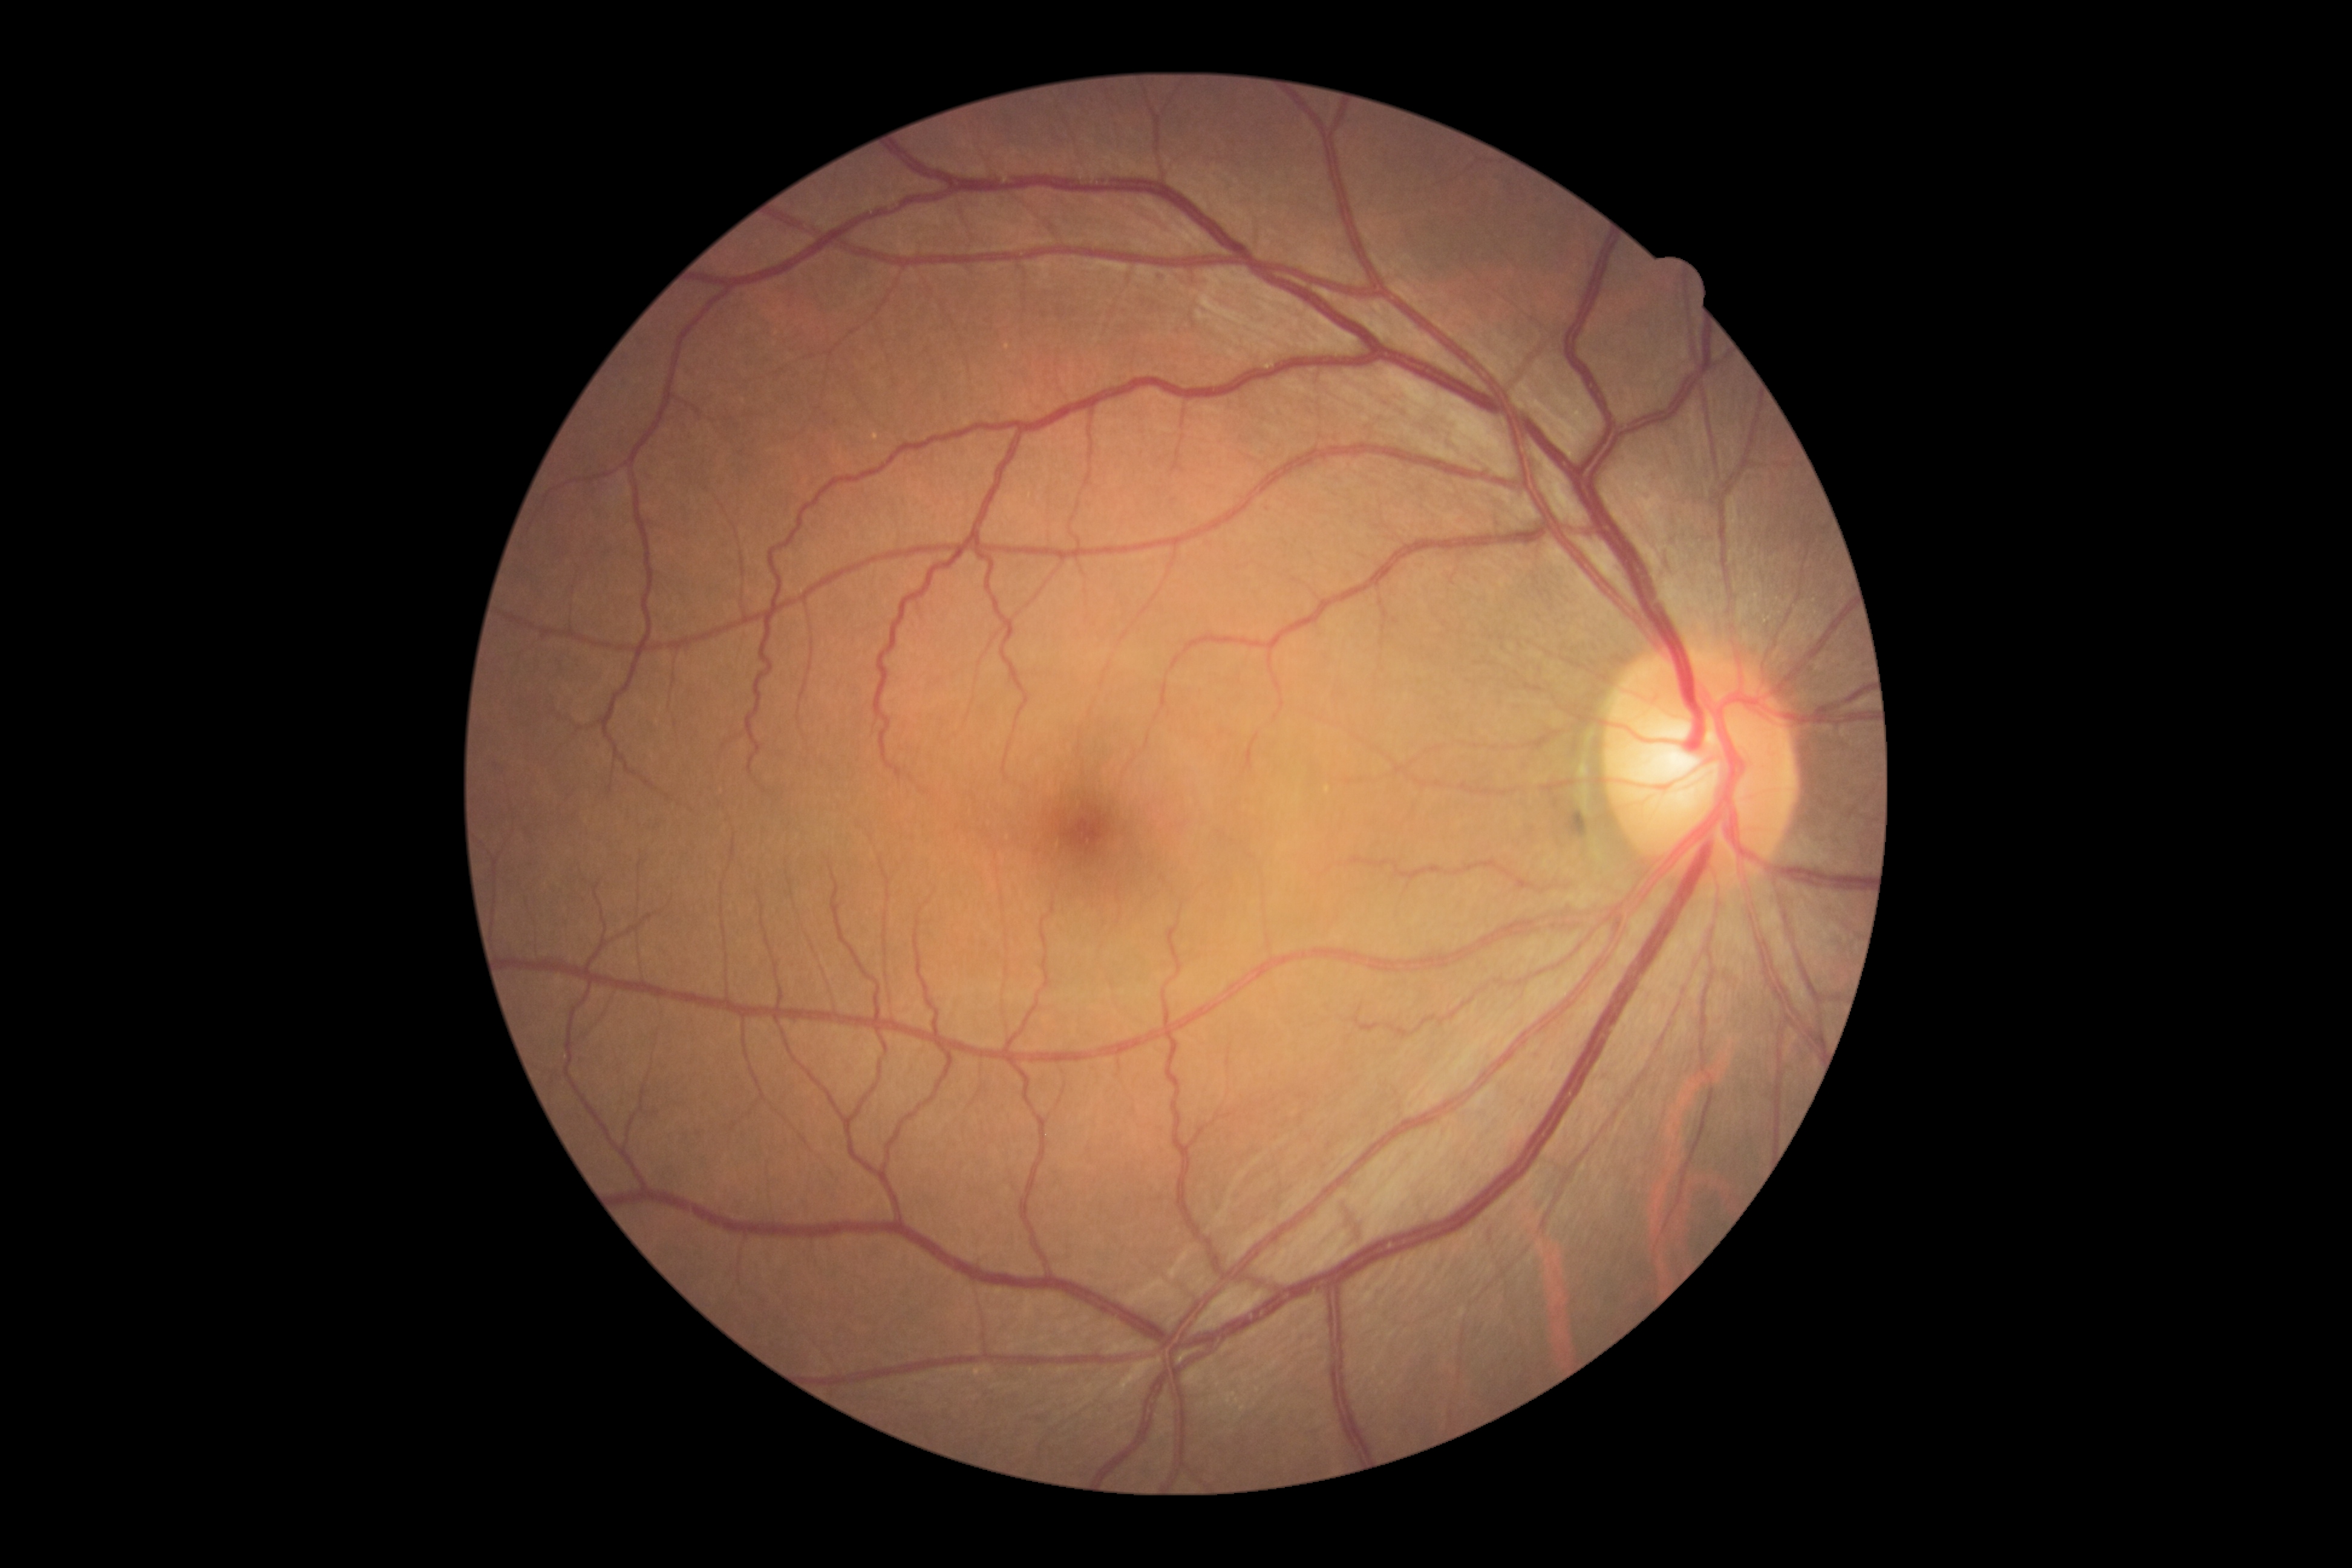
{"dr_grade": "grade 0 (no apparent retinopathy)"}